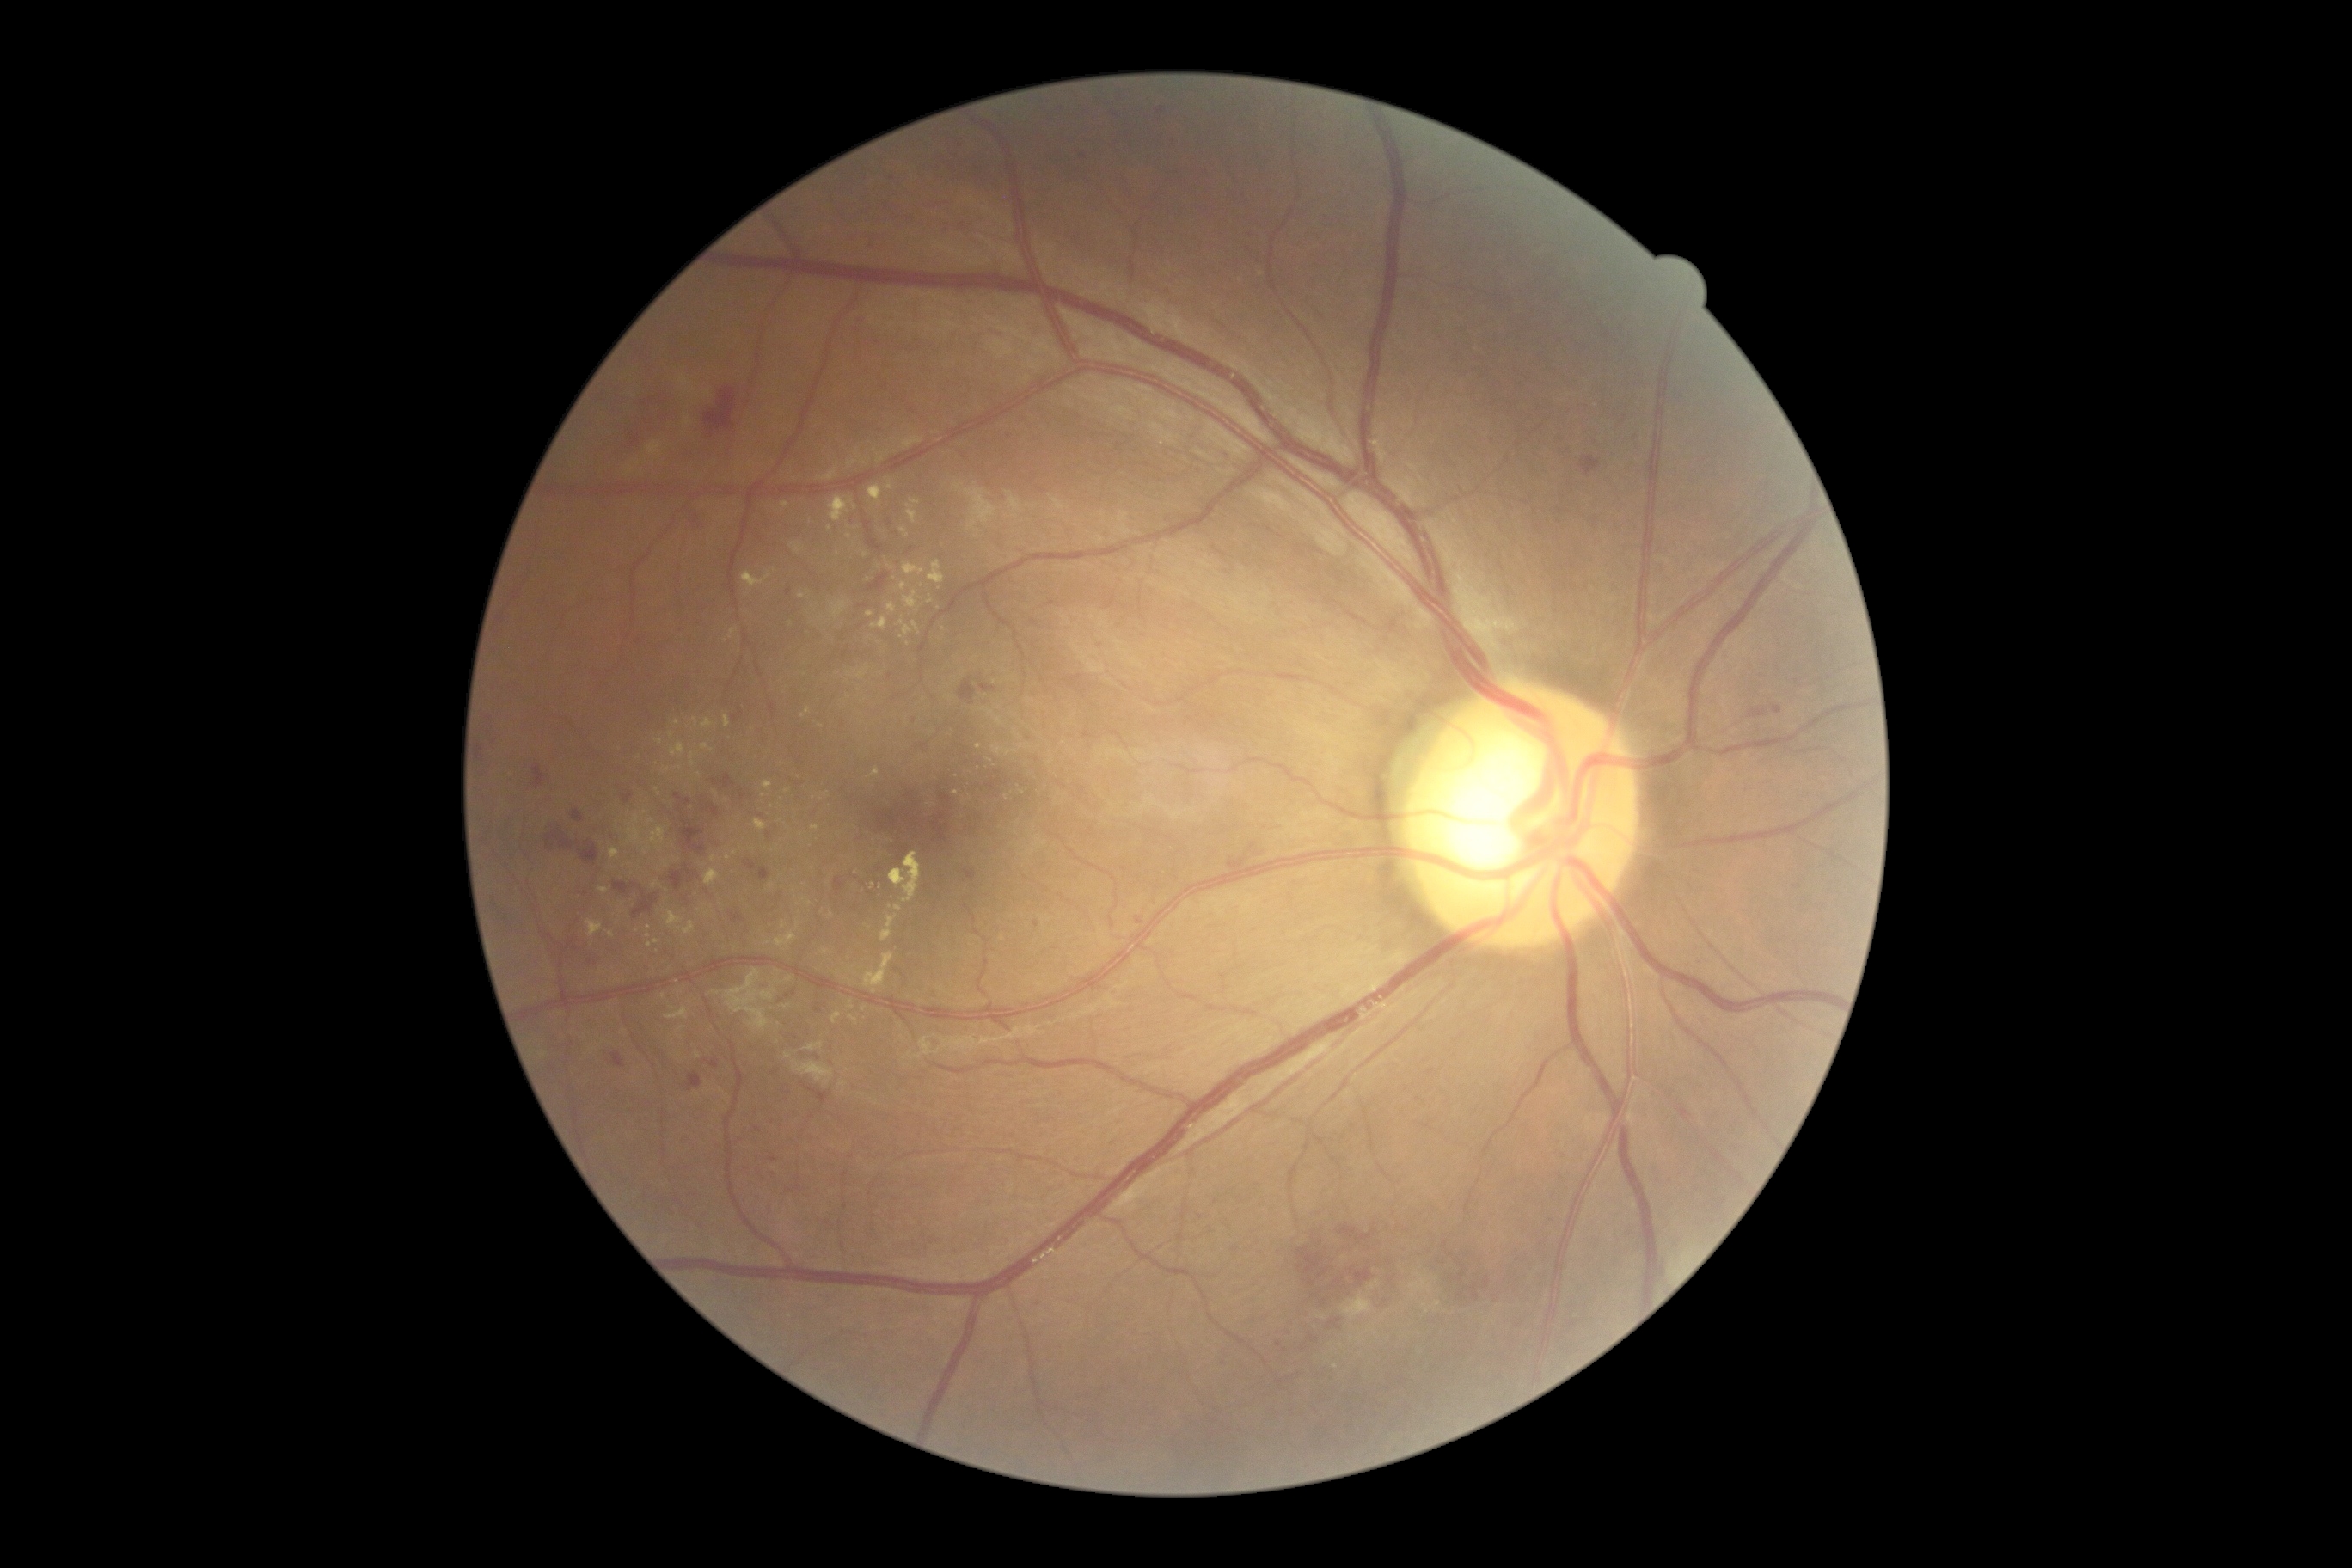 Diabetic retinopathy (DR): 2/4; non-proliferative diabetic retinopathy
A subset of detected lesions:
hard exudates (EXs) (continued): bbox=(929, 561, 945, 584); bbox=(1342, 1295, 1373, 1321); bbox=(702, 744, 714, 752); bbox=(711, 855, 718, 864); bbox=(867, 769, 881, 780); bbox=(873, 616, 888, 630); bbox=(725, 716, 732, 728); bbox=(587, 921, 603, 938)
Small EXs near pt(667, 770); pt(790, 980); pt(876, 1103); pt(769, 943); pt(931, 601); pt(957, 793); pt(729, 859); pt(612, 934); pt(903, 587)
hemorrhages (HEs) (continued): bbox=(745, 861, 756, 871); bbox=(702, 804, 721, 818); bbox=(835, 878, 845, 895); bbox=(668, 864, 699, 891); bbox=(546, 828, 601, 866); bbox=(1309, 1335, 1320, 1344); bbox=(572, 811, 584, 823); bbox=(1227, 855, 1263, 874); bbox=(534, 766, 546, 788); bbox=(563, 938, 615, 969); bbox=(1249, 843, 1263, 857); bbox=(713, 775, 737, 790); bbox=(1065, 675, 1087, 695); bbox=(1438, 1261, 1447, 1266)
Small HEs near pt(1007, 784); pt(586, 895); pt(998, 772)